Macula-centered field
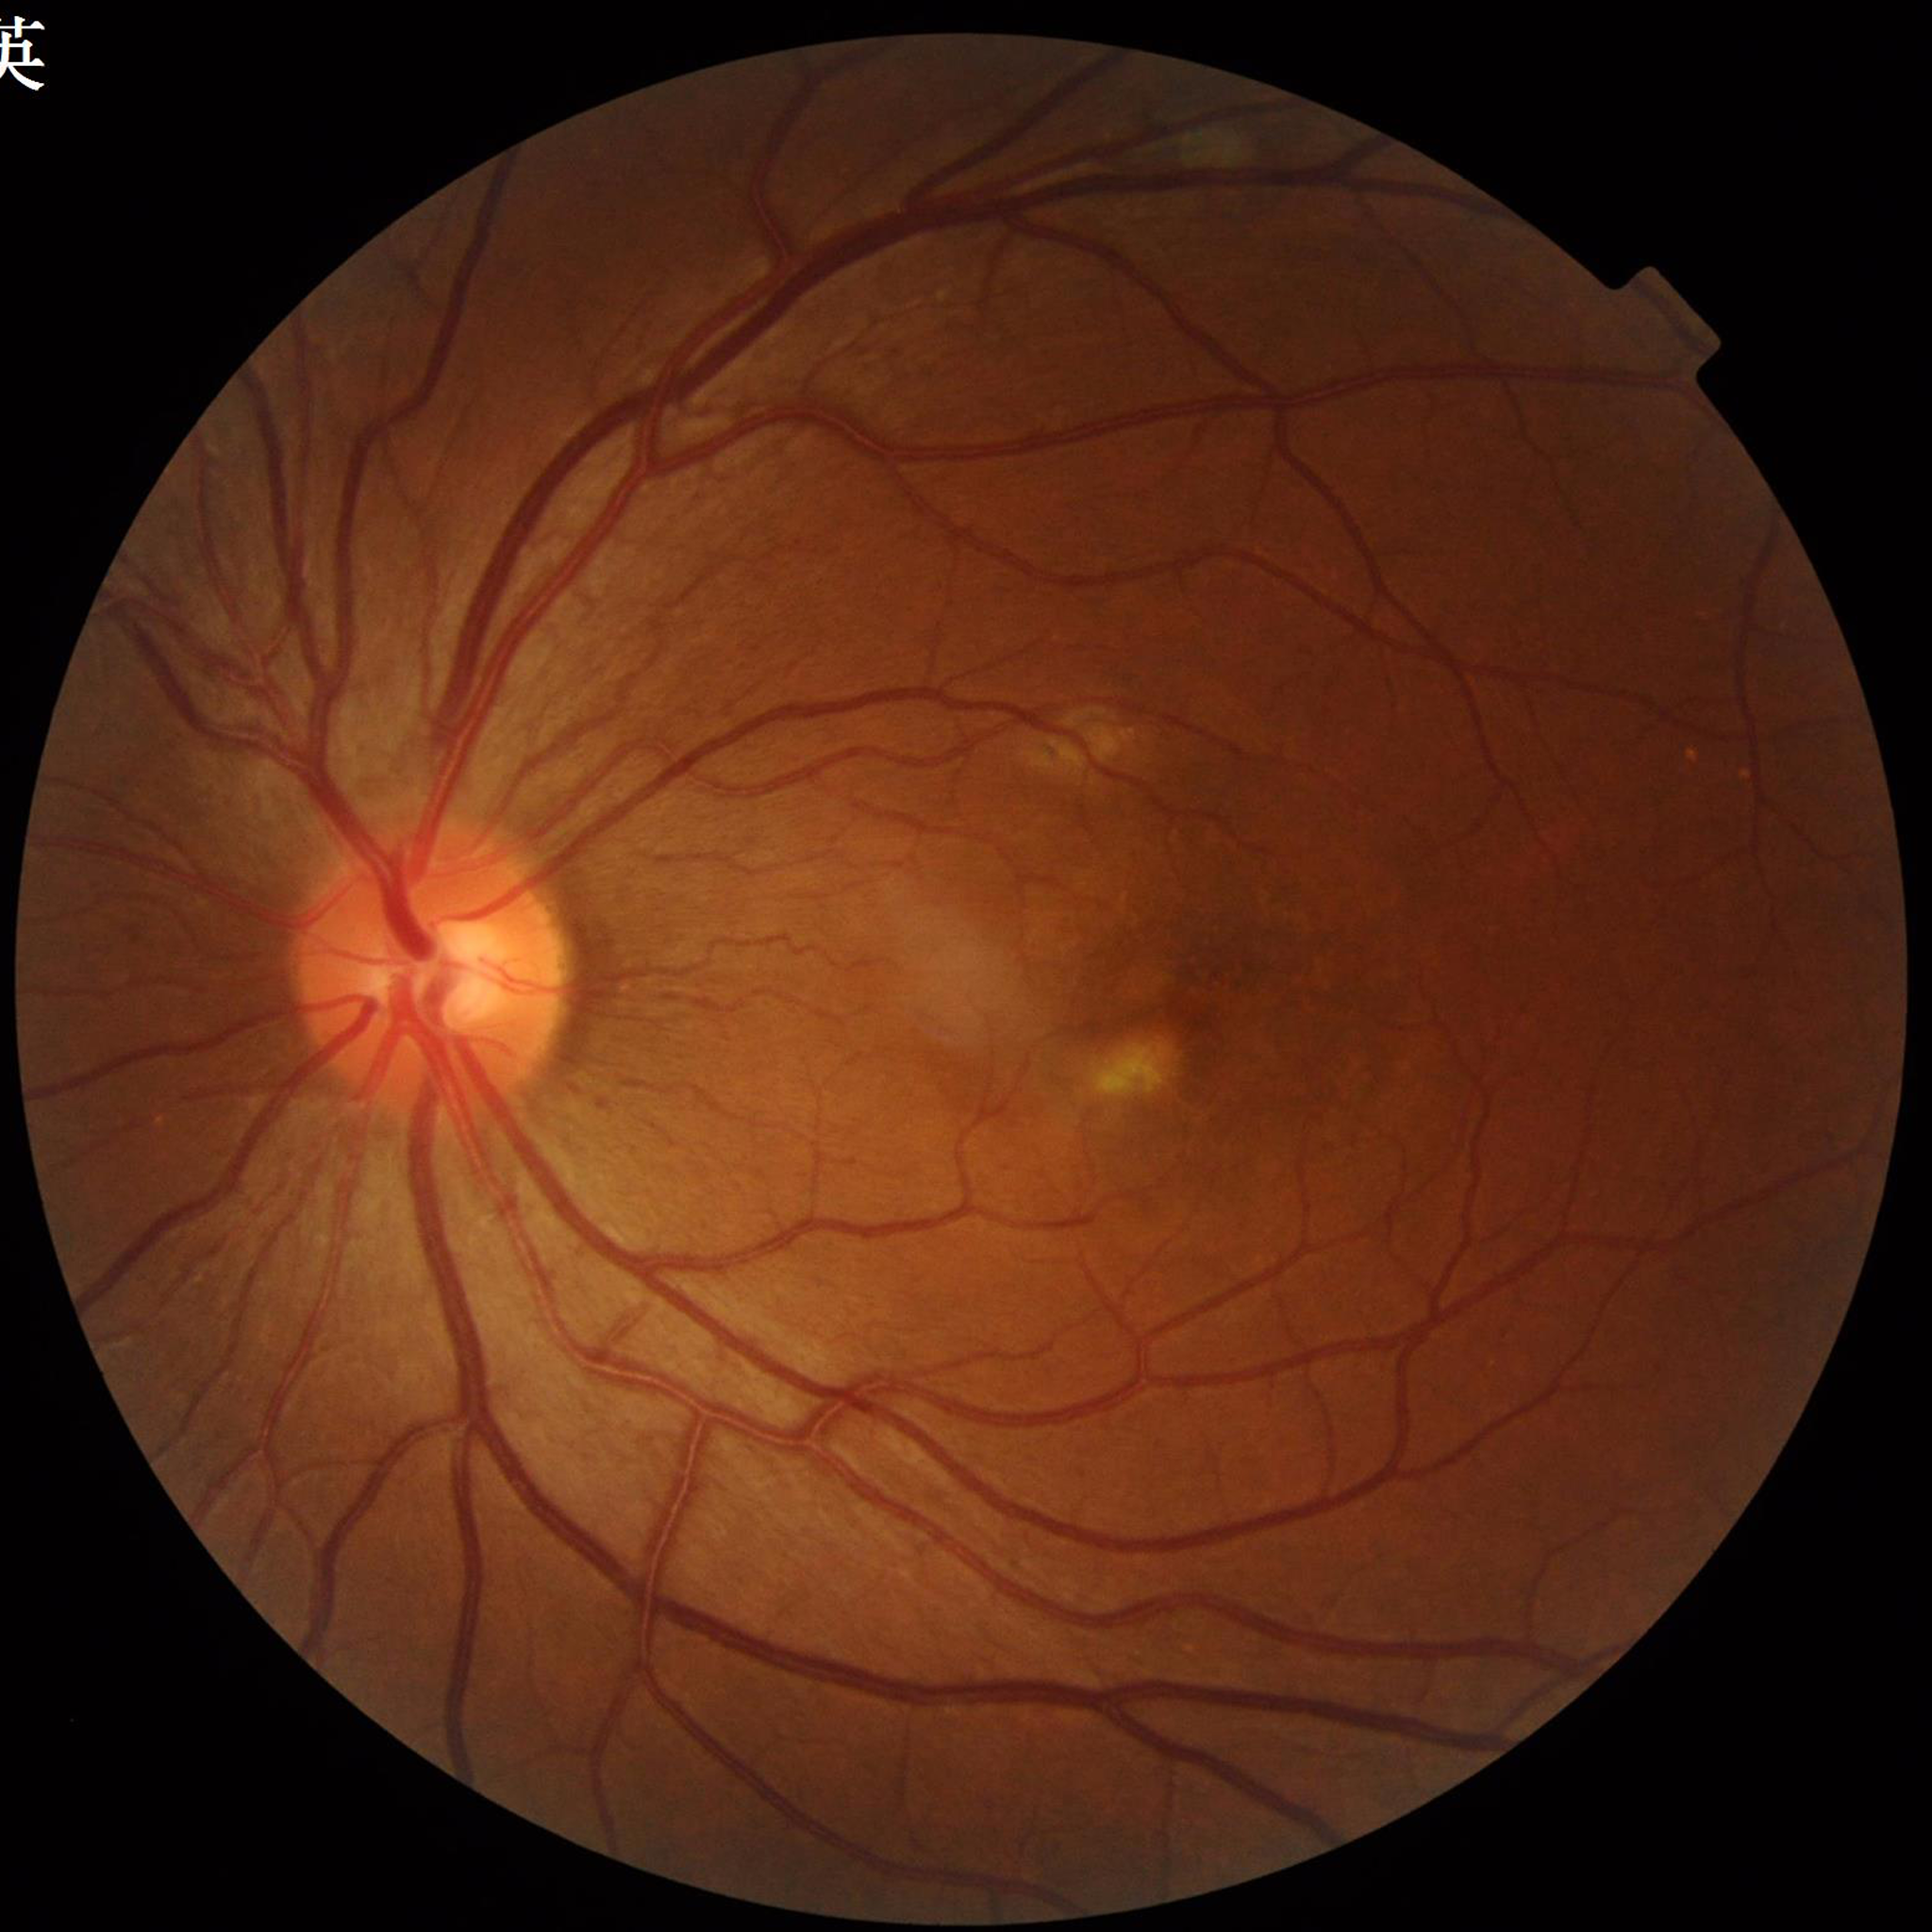
Disease class: age-related macular degeneration (AMD); Quality: no quality issues identified.